555x419
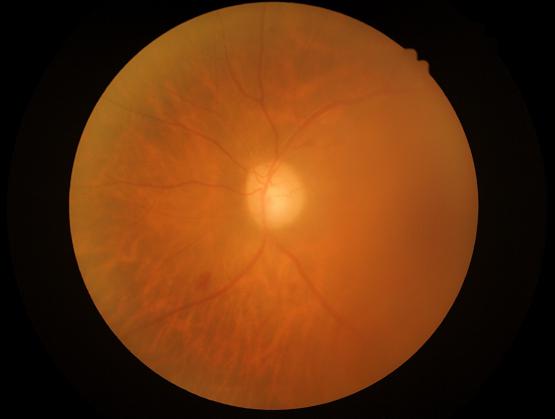

Overall image quality is poor. Out of focus; structures are indistinct.